45° FOV, 2352 by 1568 pixels, color fundus image.
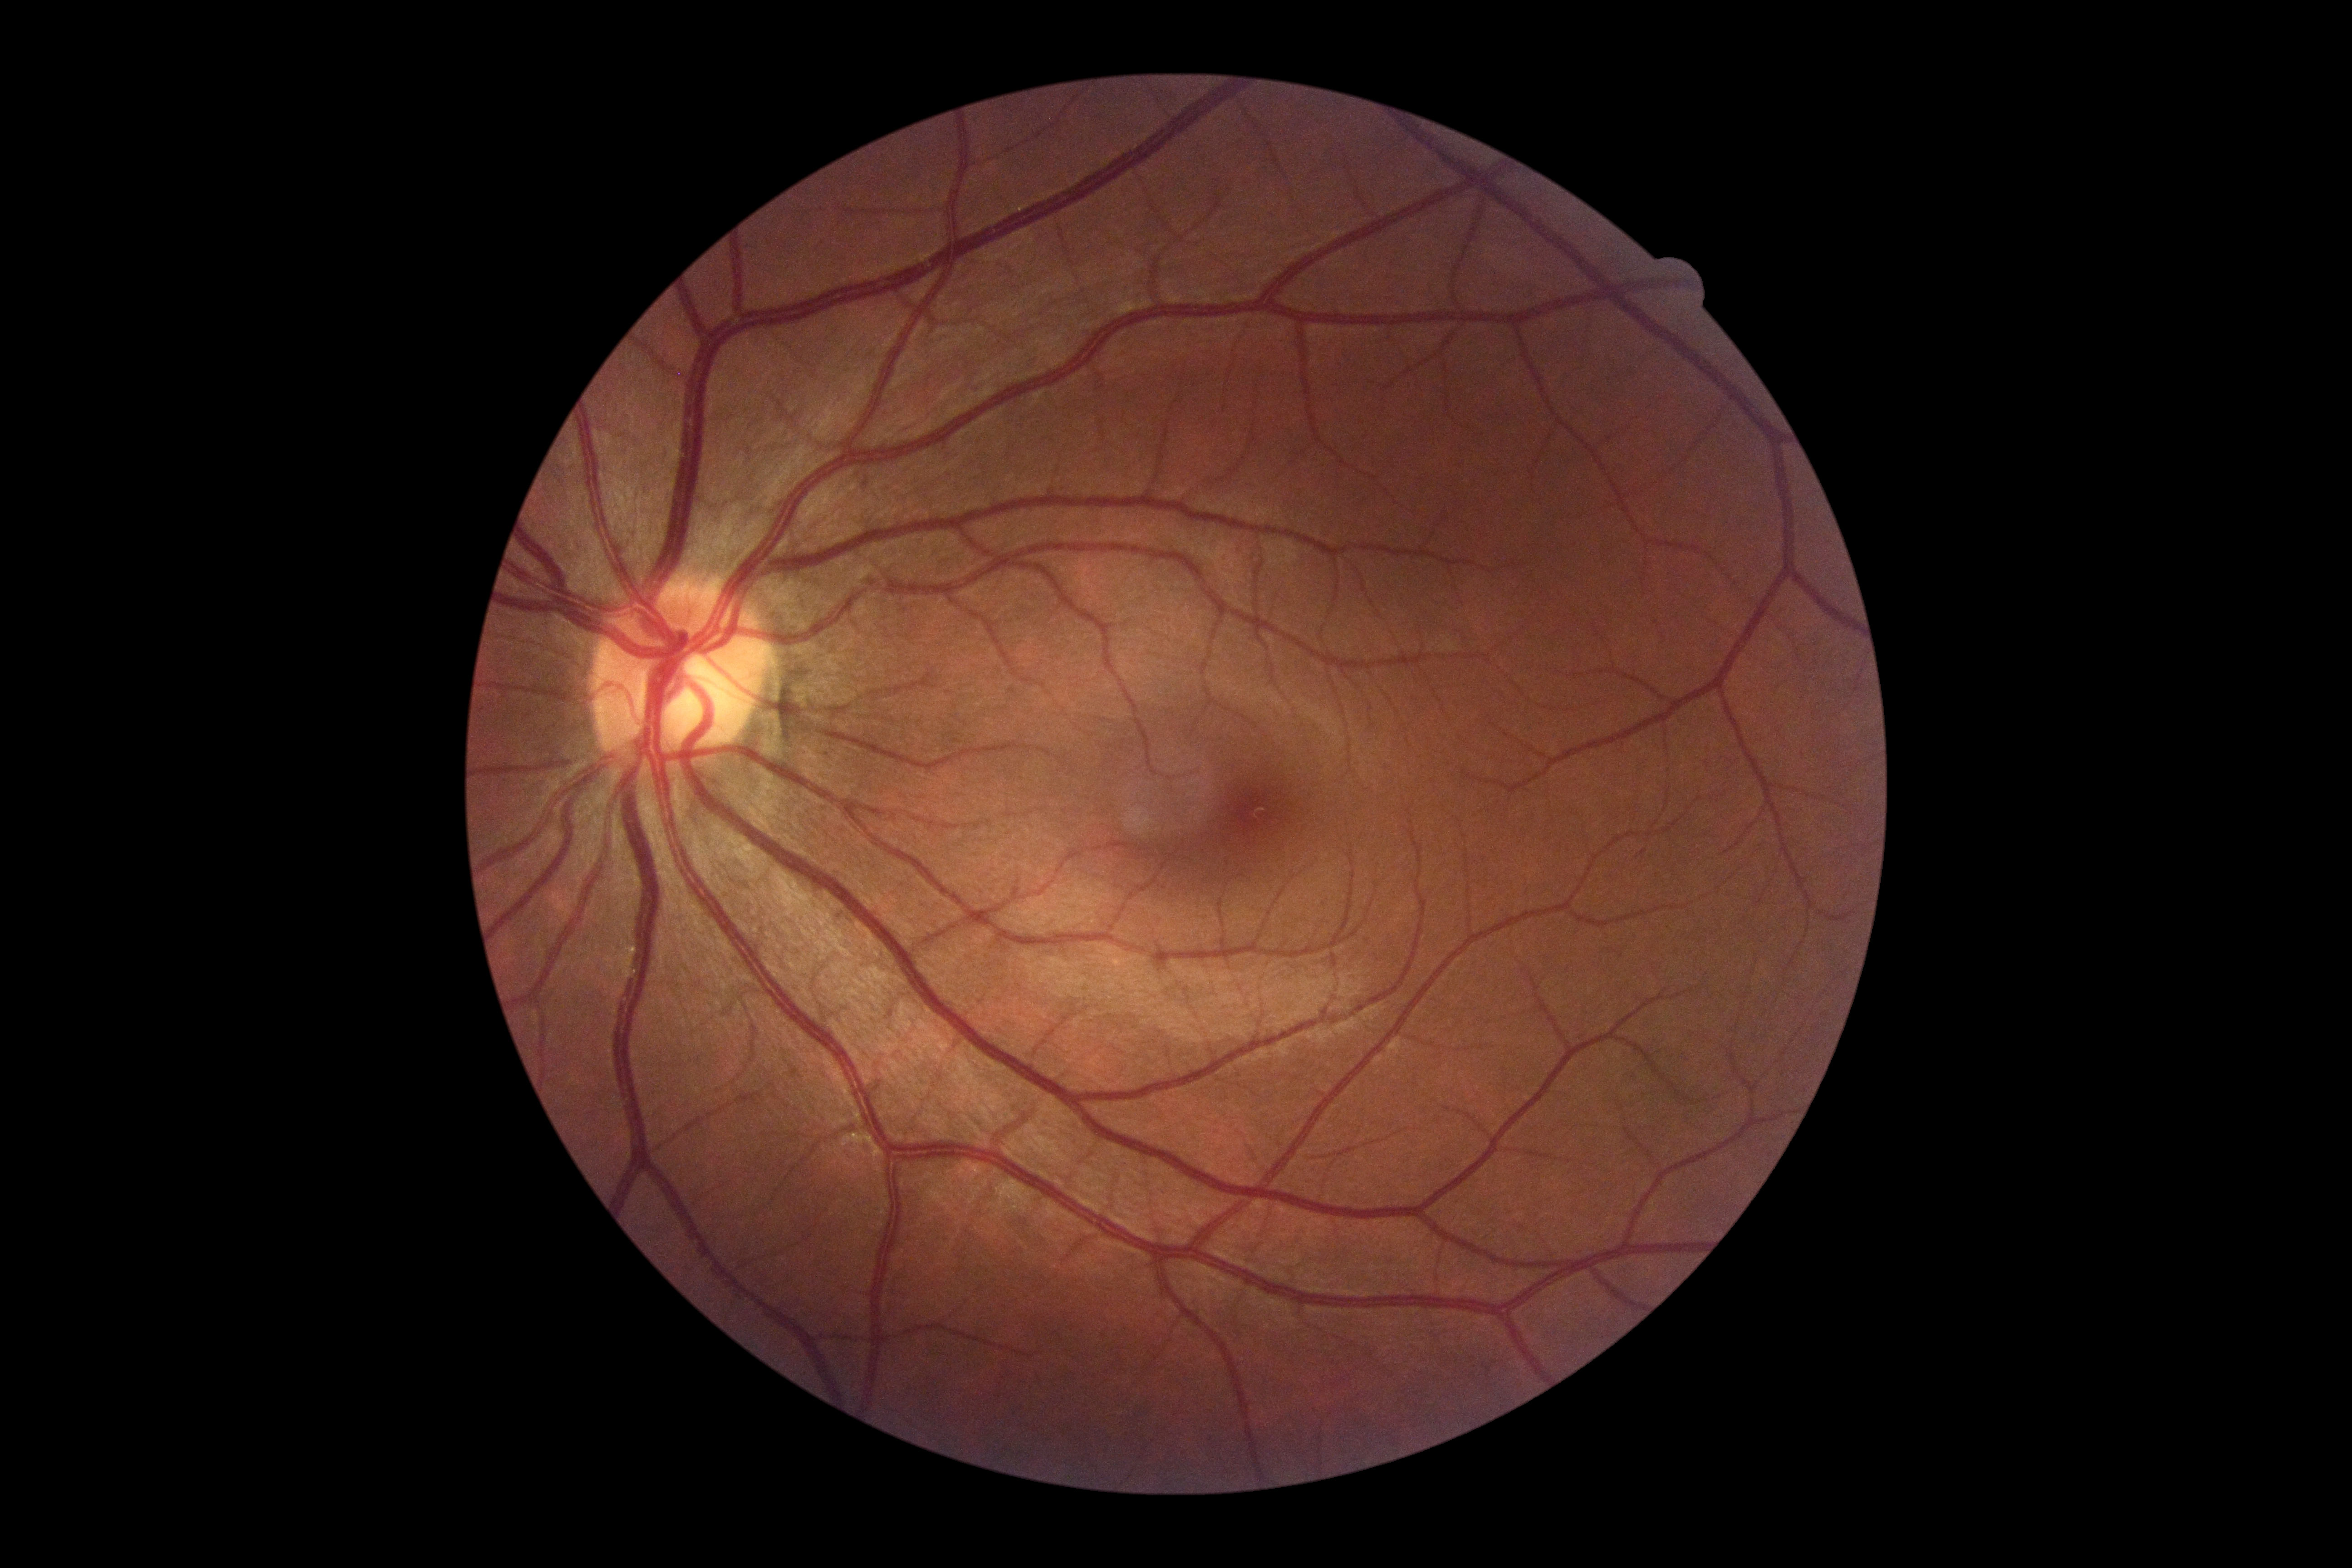 {
  "dr_grade": "0 (no apparent retinopathy)"
}